Central posterior field, image size 2228x1652, mydriatic (tropicamide and phenylephrine), captured on a Topcon TRC-50DX fundus camera:
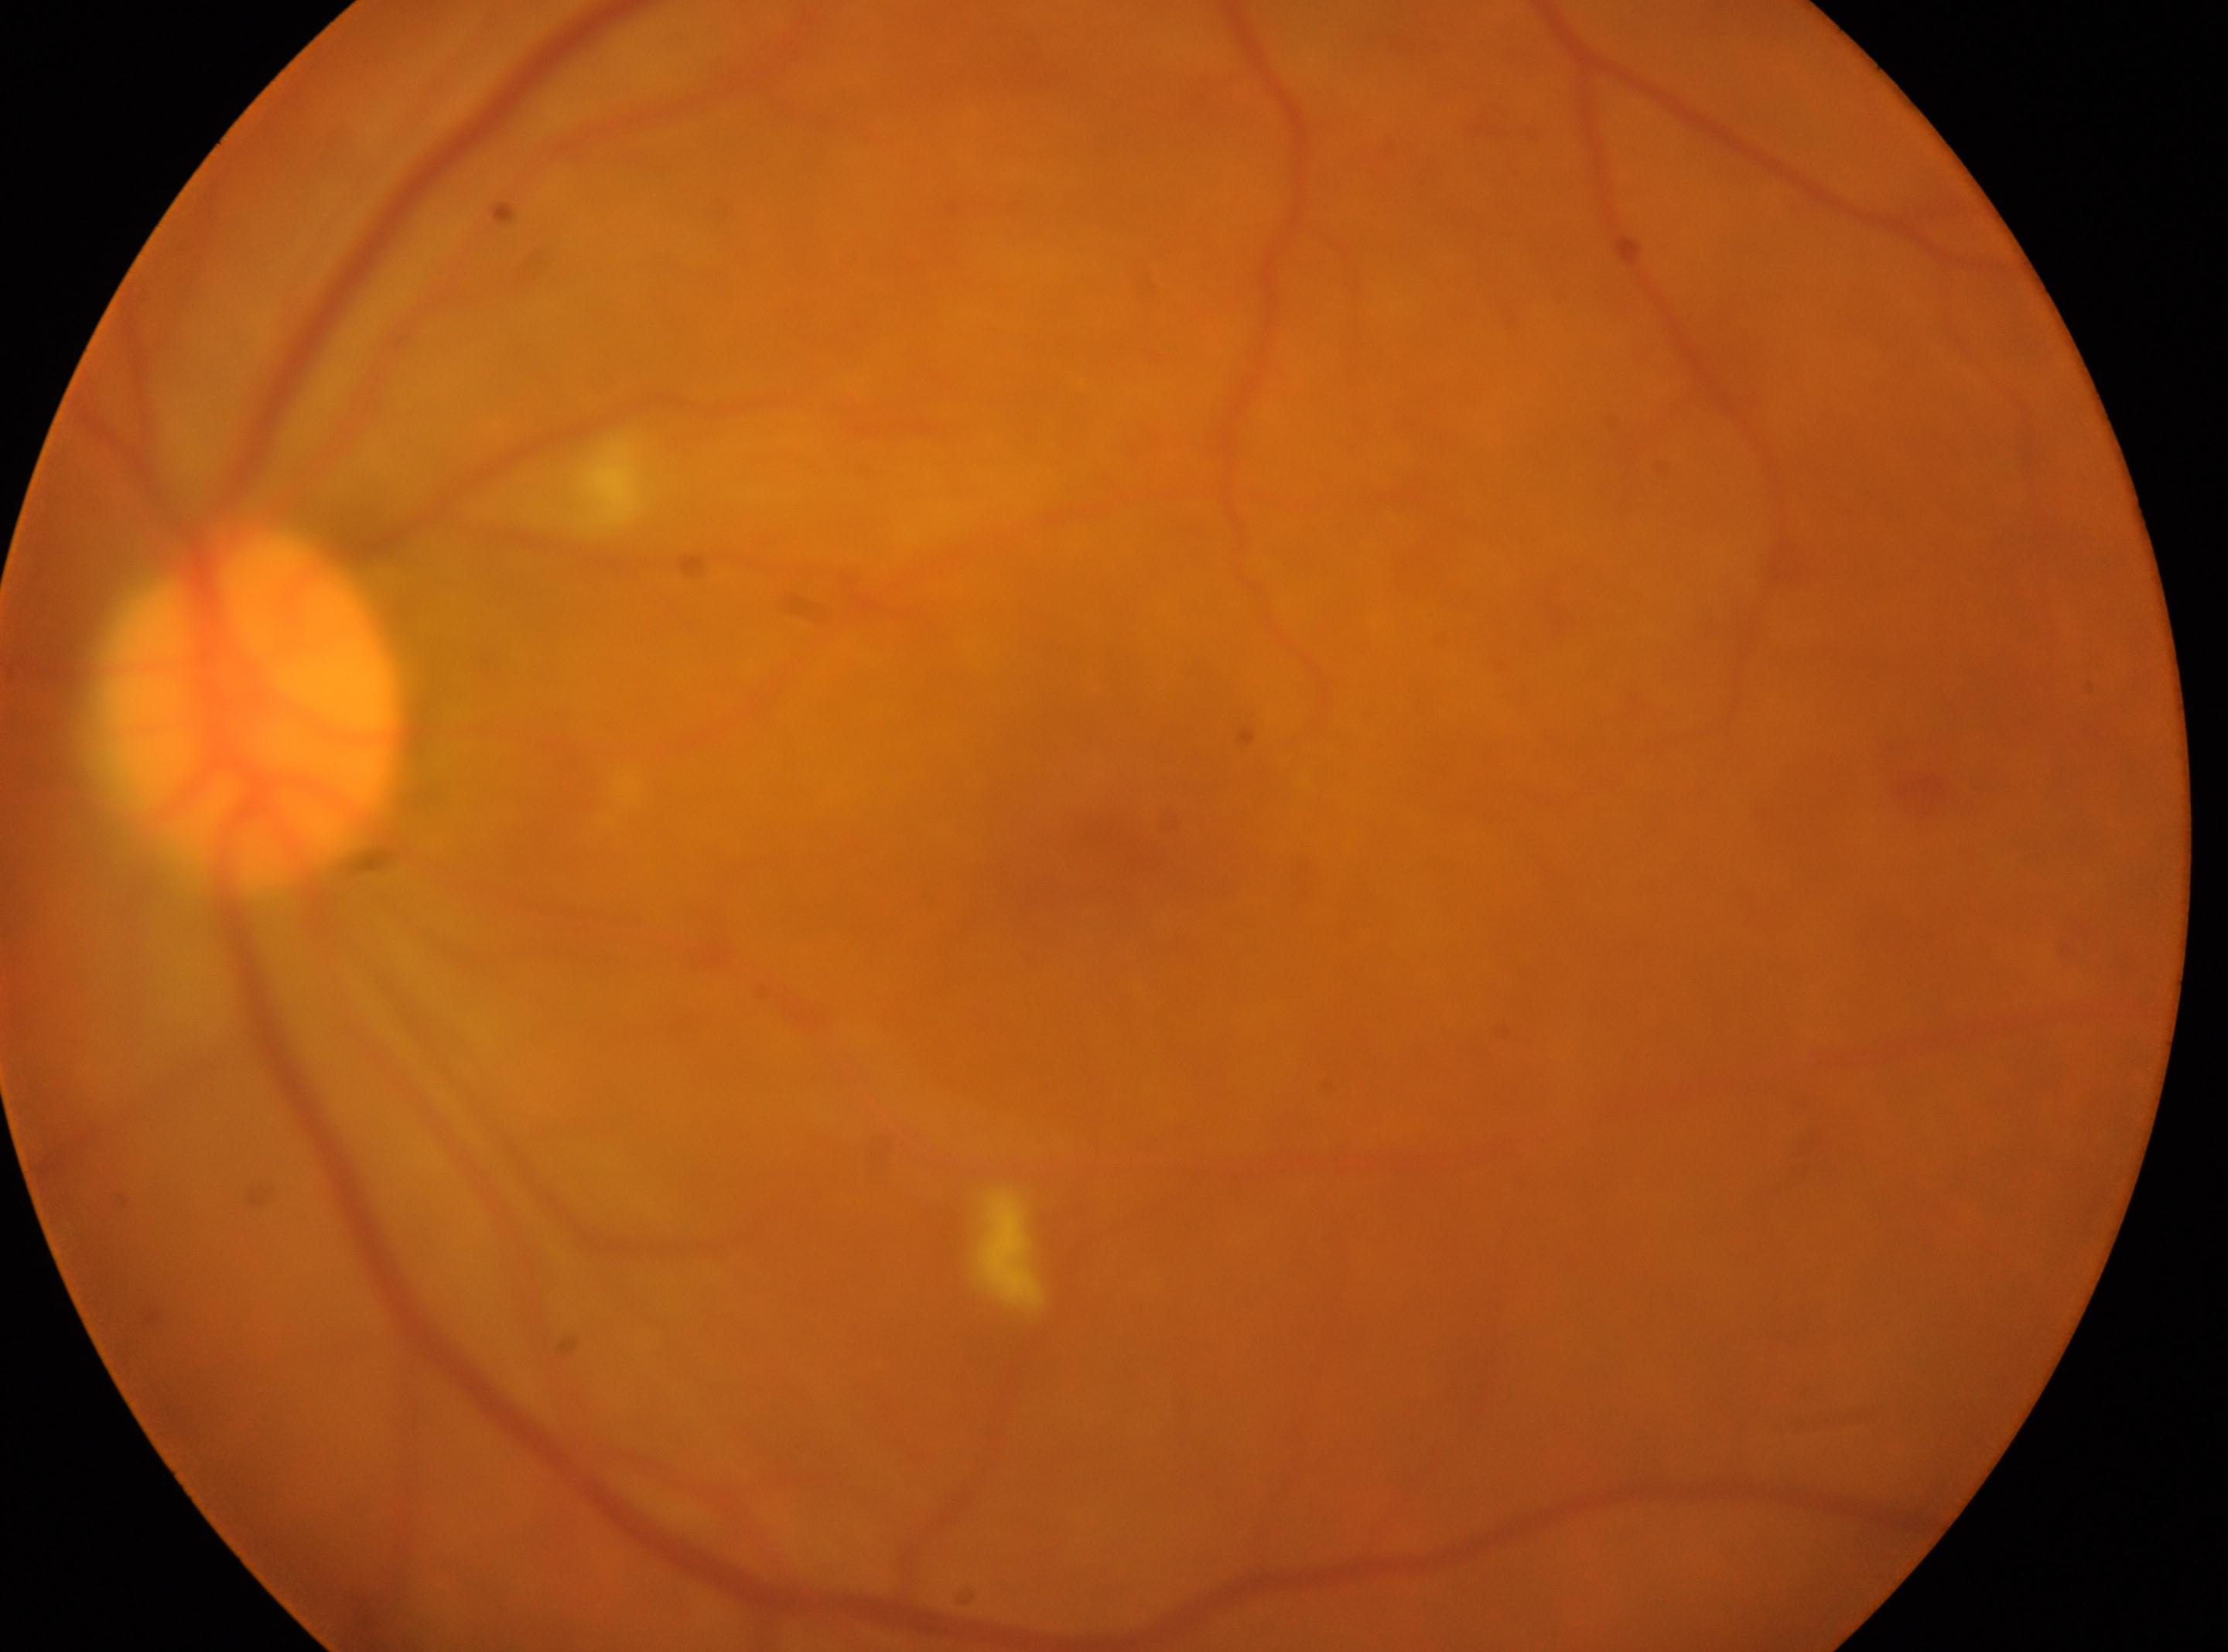

  optic_disc: x=246, y=715
  dr_grade: moderate NPDR (grade 2)
  dr_category: non-proliferative diabetic retinopathy
  fovea: x=1085, y=865
  eye: left